45° FOV; CFP: 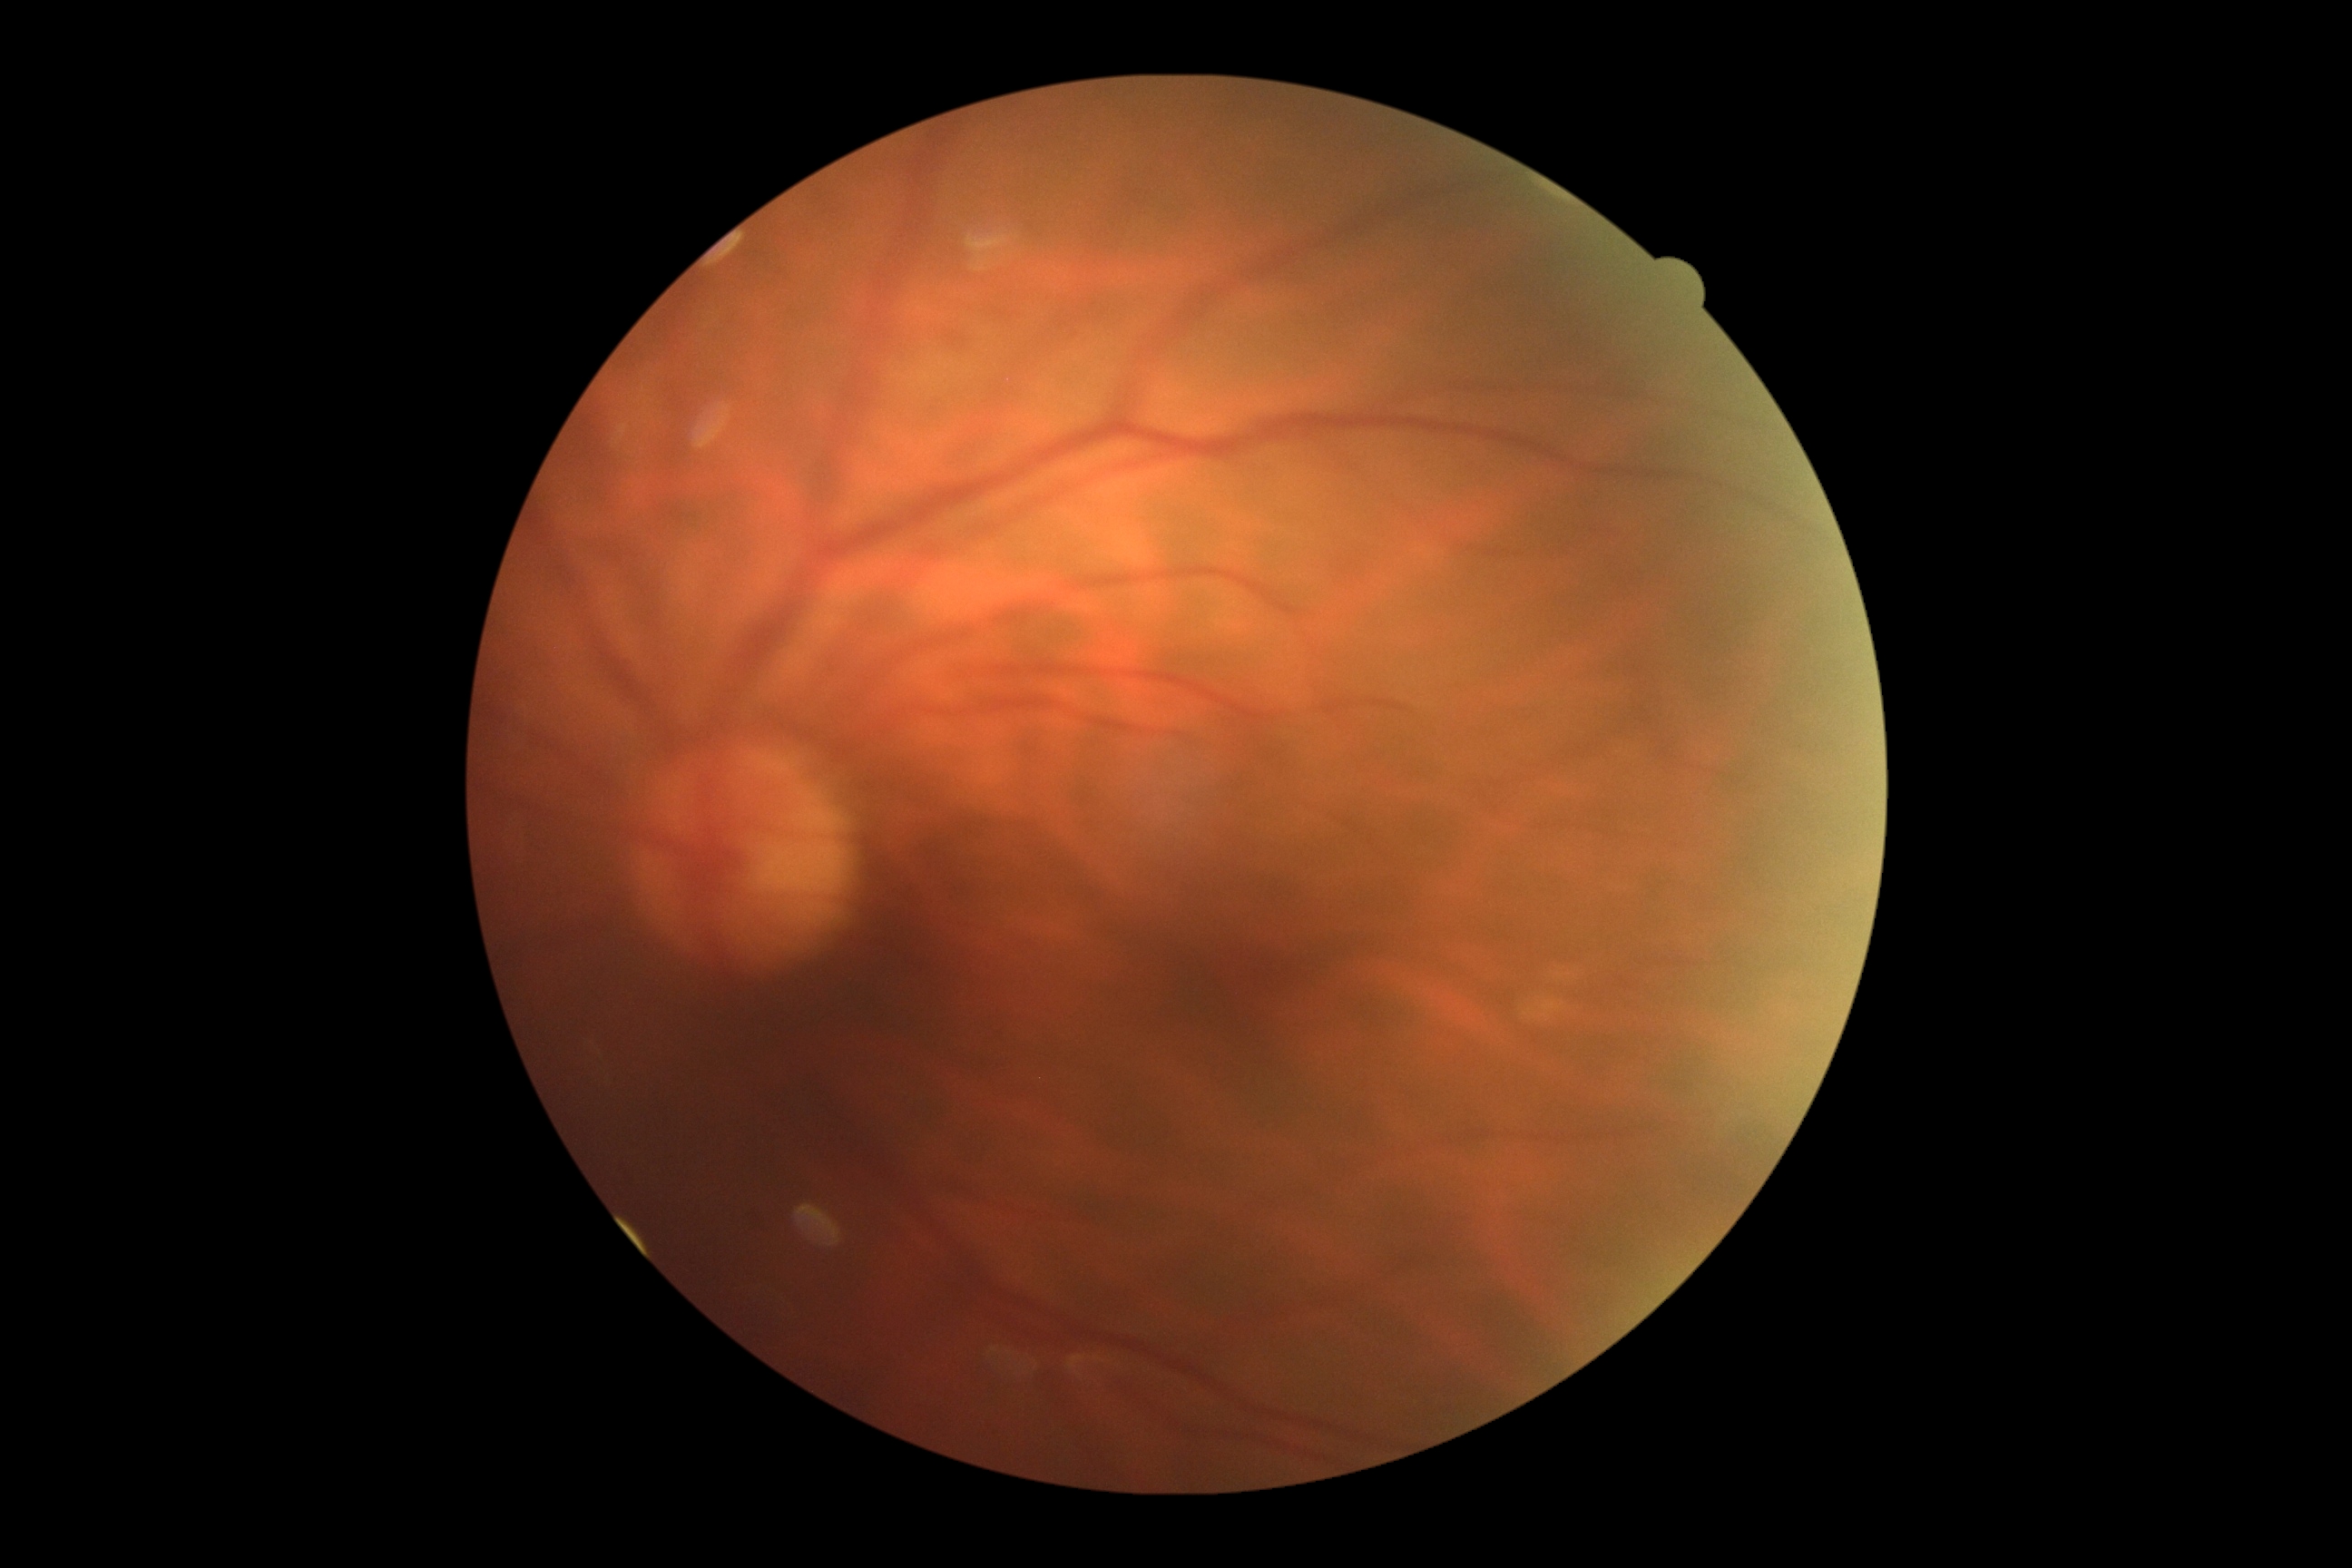

diabetic retinopathy (DR): 0 — no visible signs of diabetic retinopathy.